Color fundus photograph. Davis DR grading — 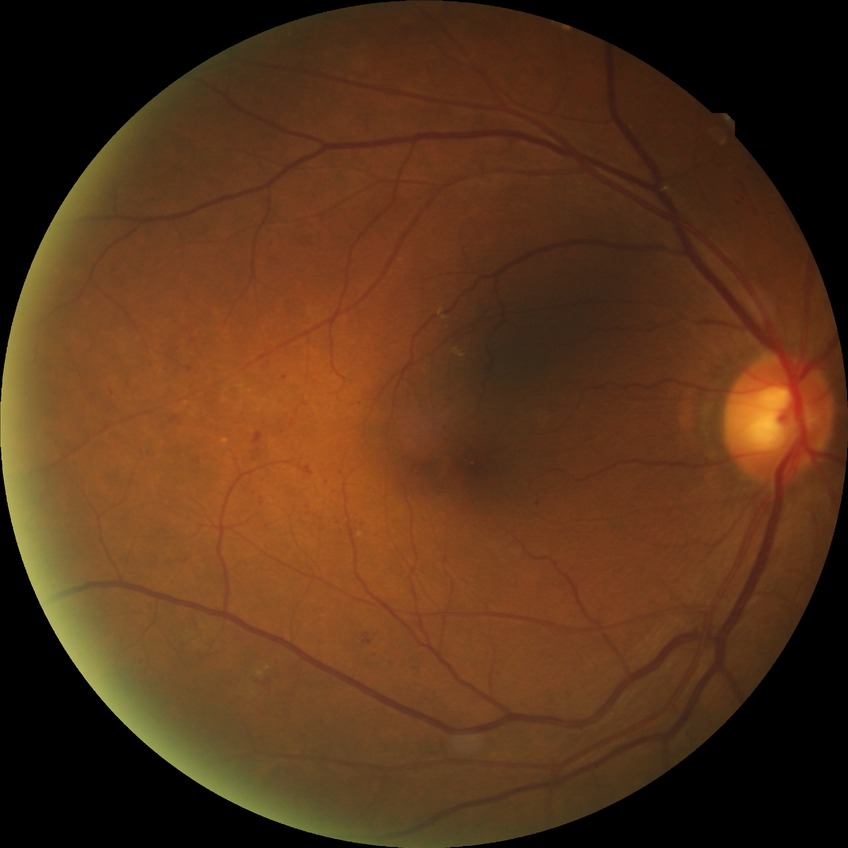

DR class@non-proliferative diabetic retinopathy; diabetic retinopathy (DR)@SDR (simple diabetic retinopathy).